Infant wide-field fundus photograph. 640 x 480 pixels
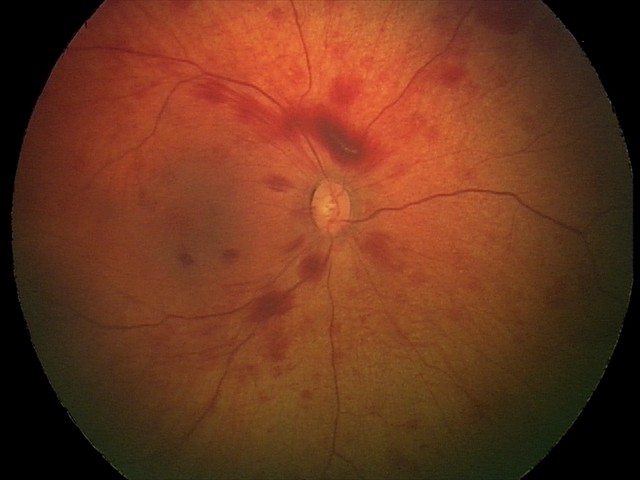

Q: What is the diagnosis from this examination?
A: retinal hemorrhages